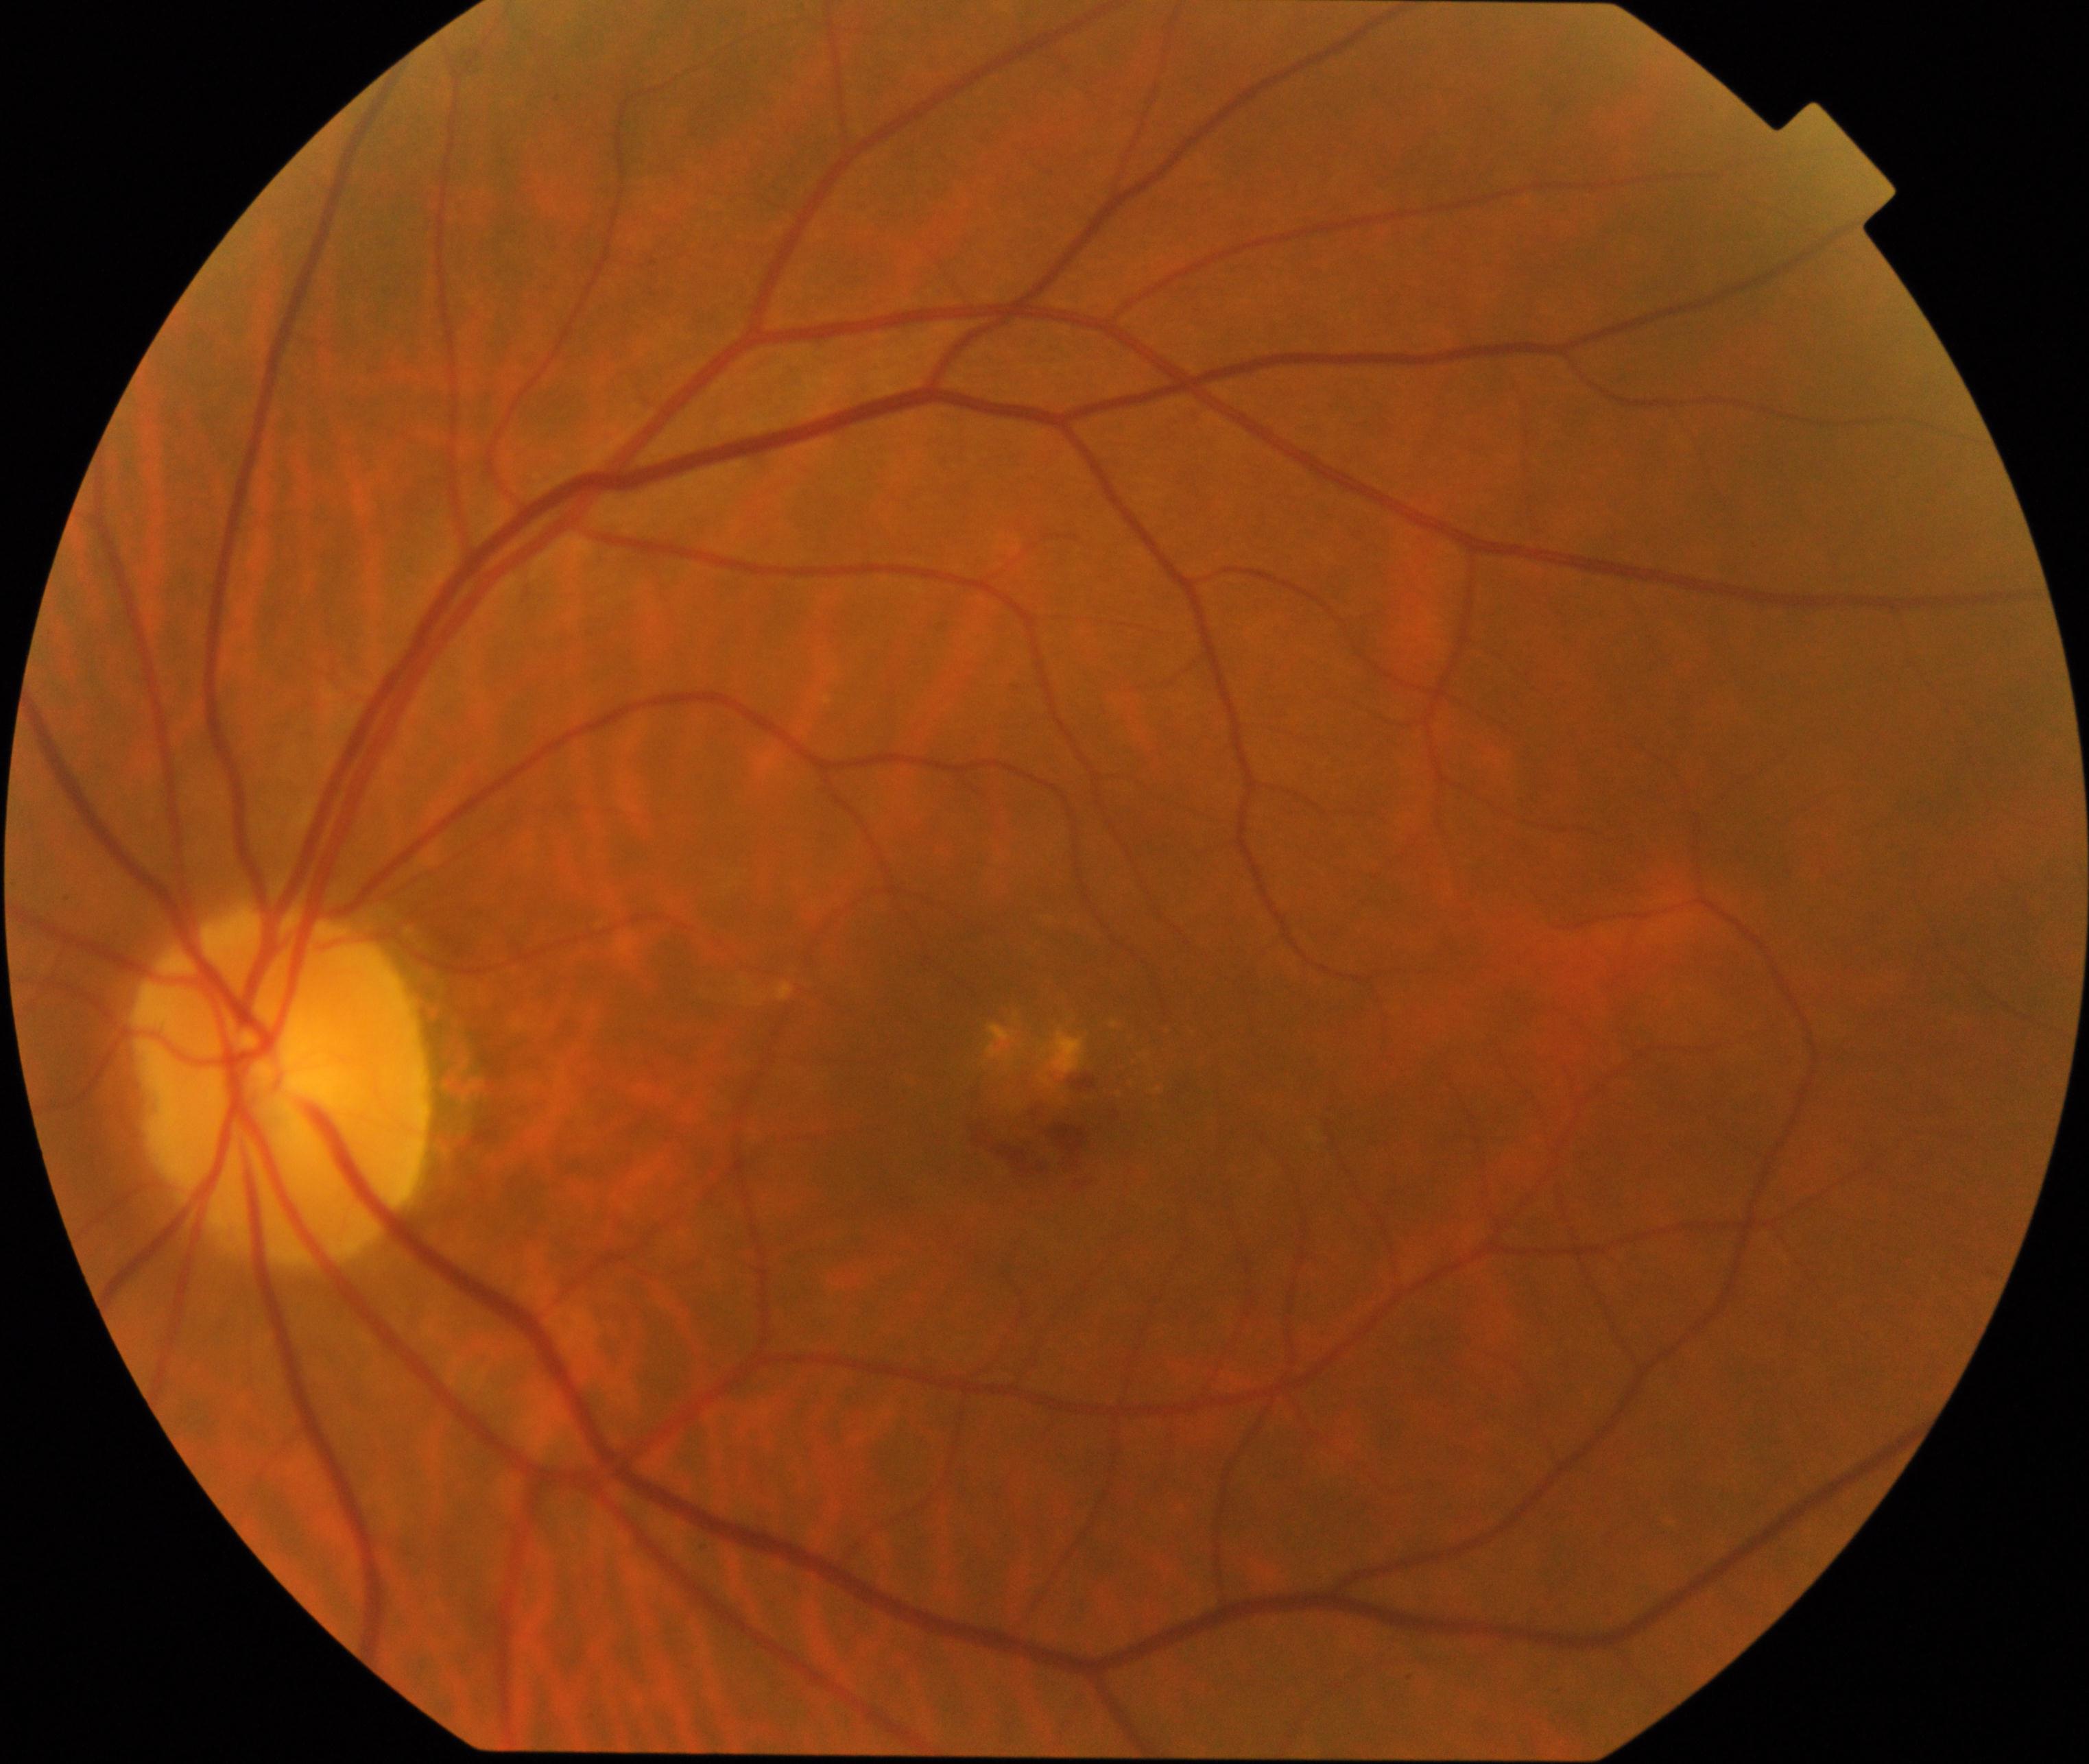
Findings: maculopathy.